FOV: 45 degrees, modified Davis grading, nonmydriatic, NIDEK AFC-230, 848x848: 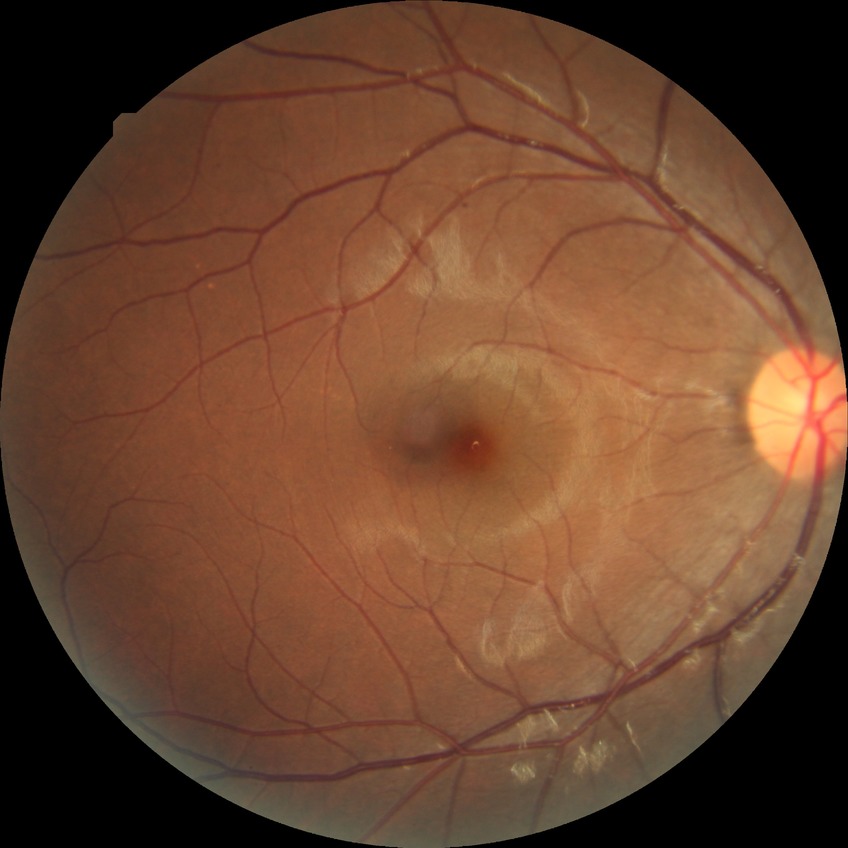
Retinopathy grade: simple diabetic retinopathy.